Image size 1659x2212
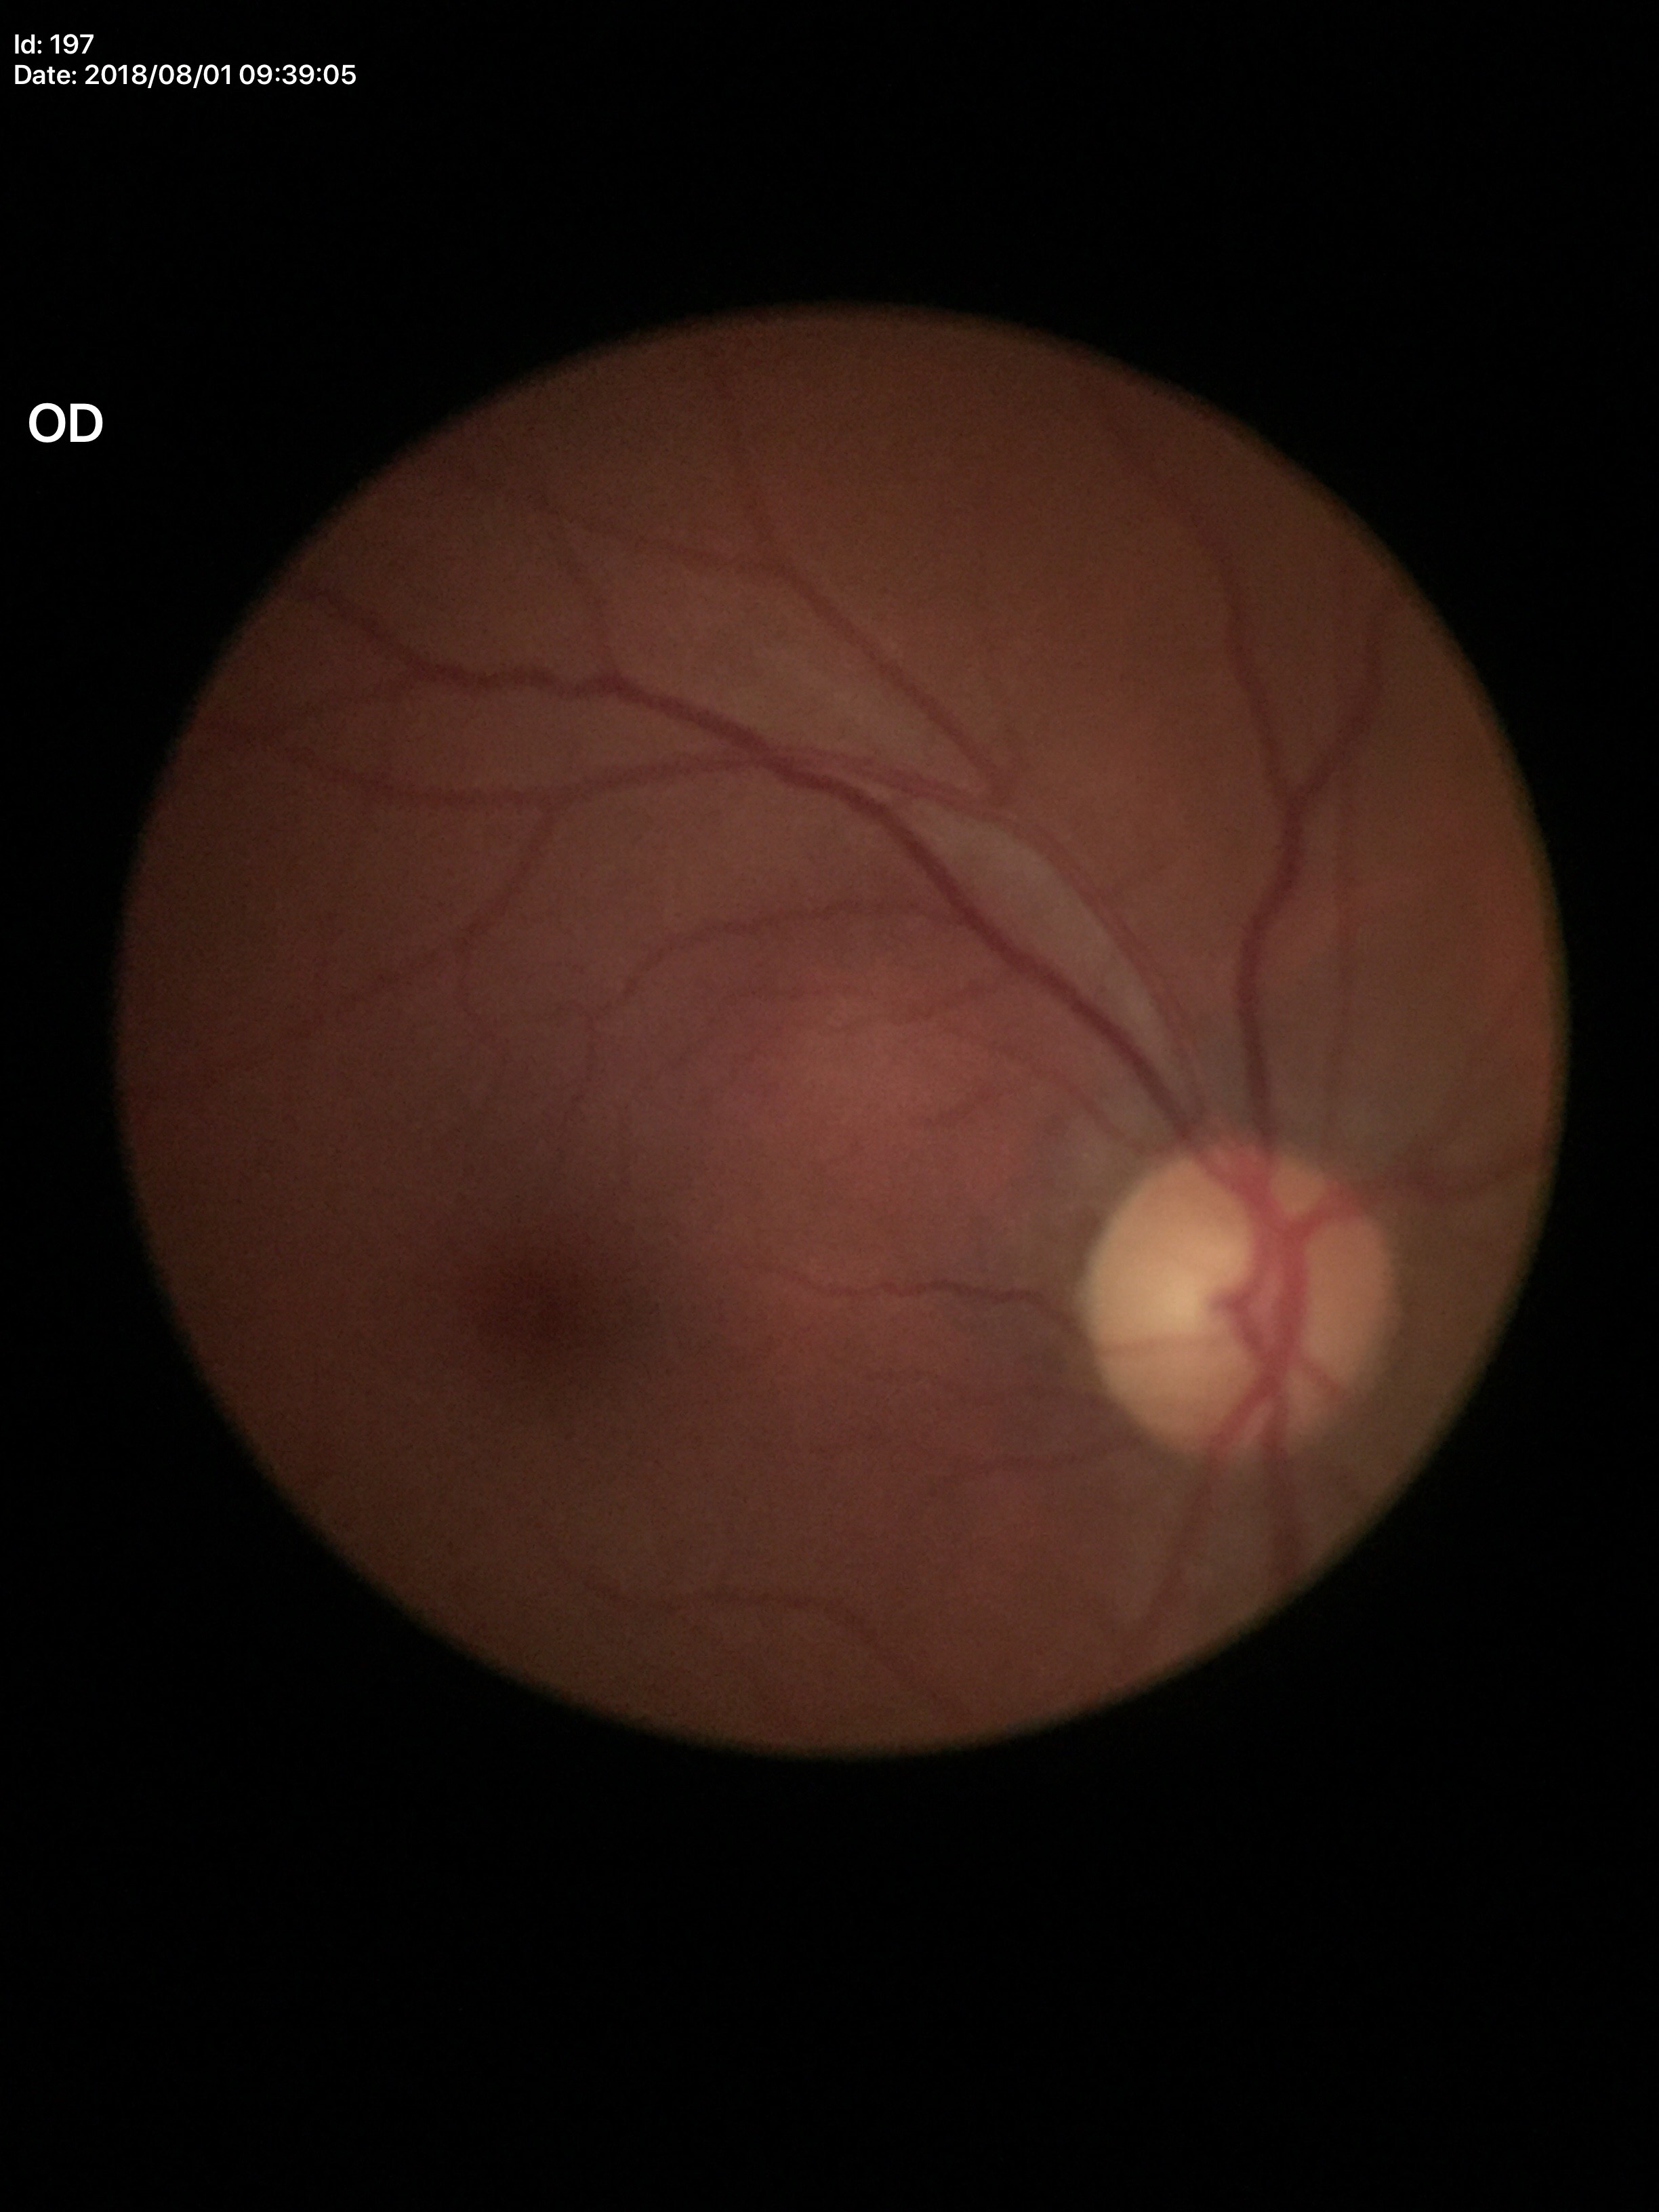 Vertical cup-to-disc ratio (VCDR): 0.50. Horizontal cup-disc ratio (HCDR) of 0.47. Glaucoma evaluation: no suspicious findings.